1440x1080px; wide-field fundus image from infant ROP screening
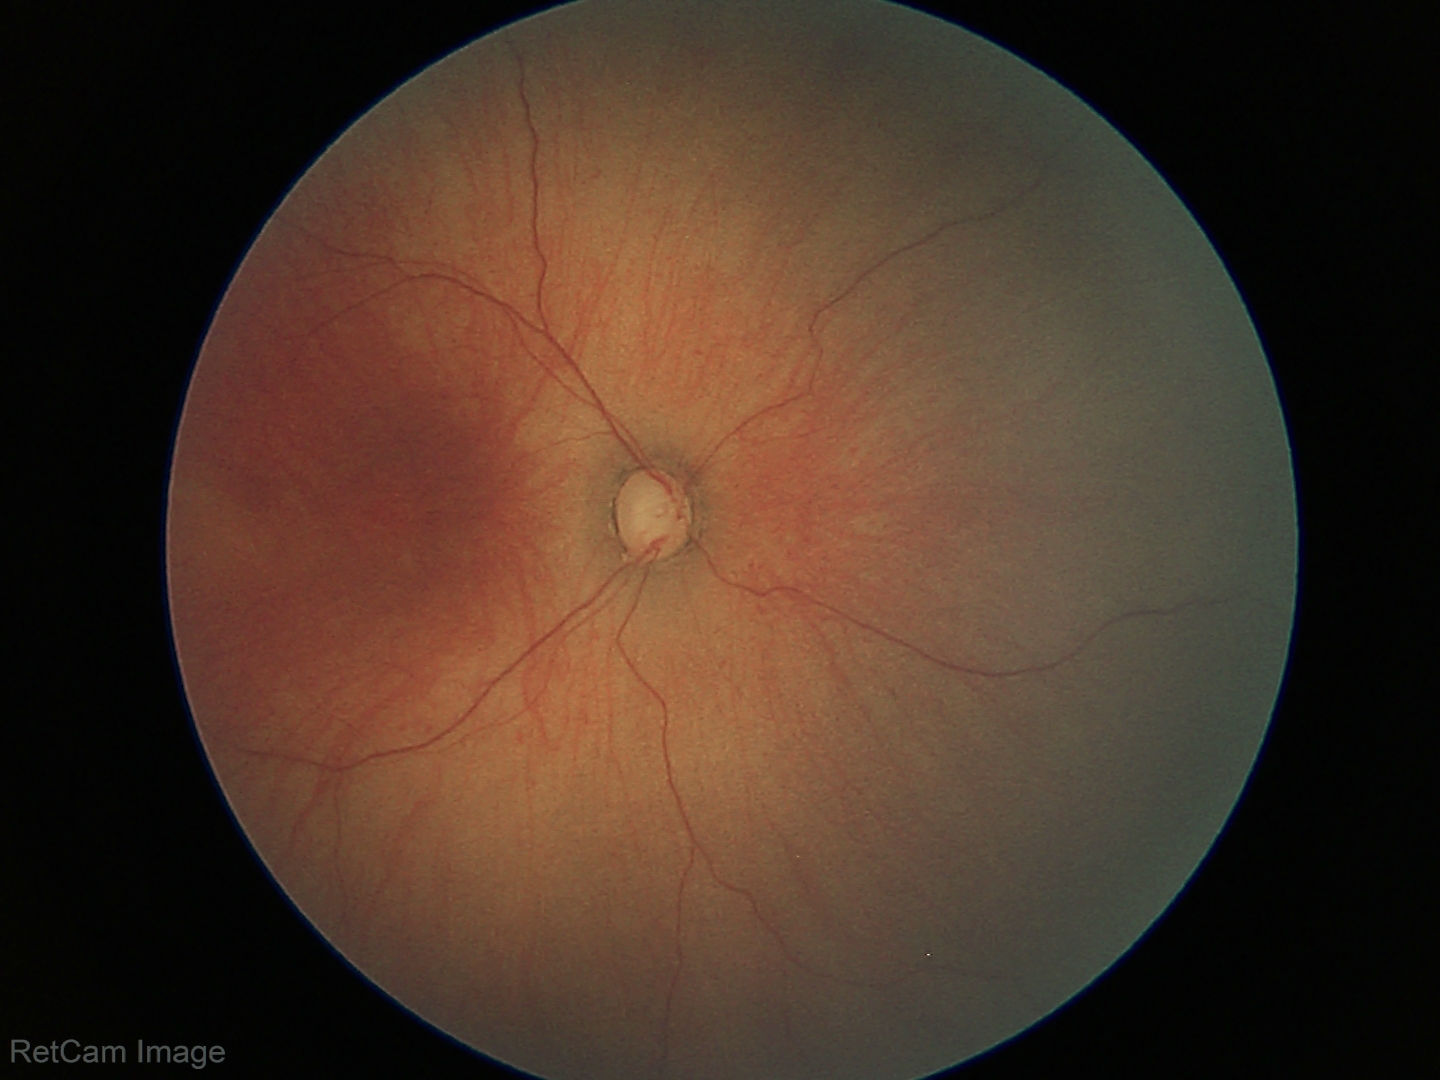

Diagnosis = retinopathy of prematurity (ROP) stage 1.